Modified Davis grading · 848x848: 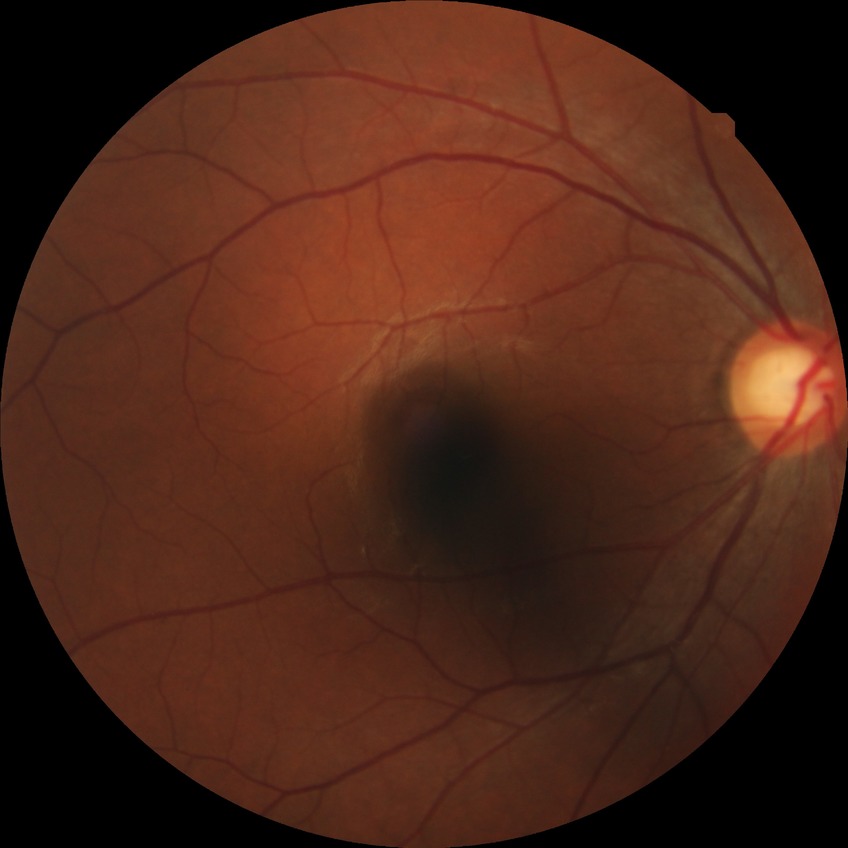 Davis grading = no diabetic retinopathy.